45° FOV. No pharmacologic dilation. Graded on the modified Davis scale.
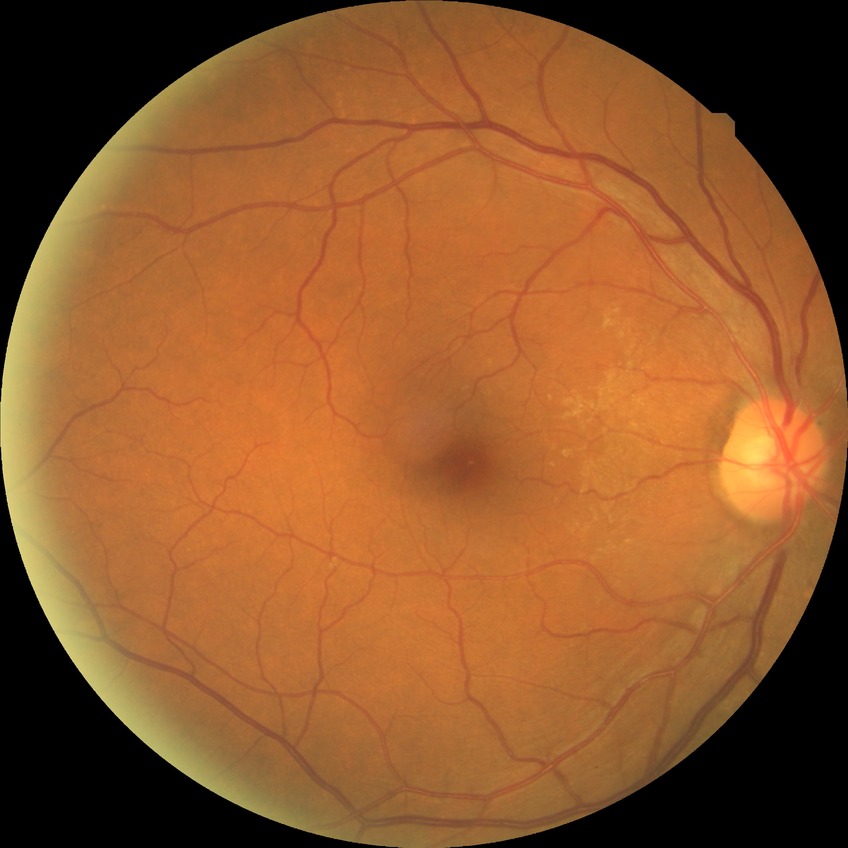
  davis_grade: no diabetic retinopathy